DR severity per modified Davis staging: 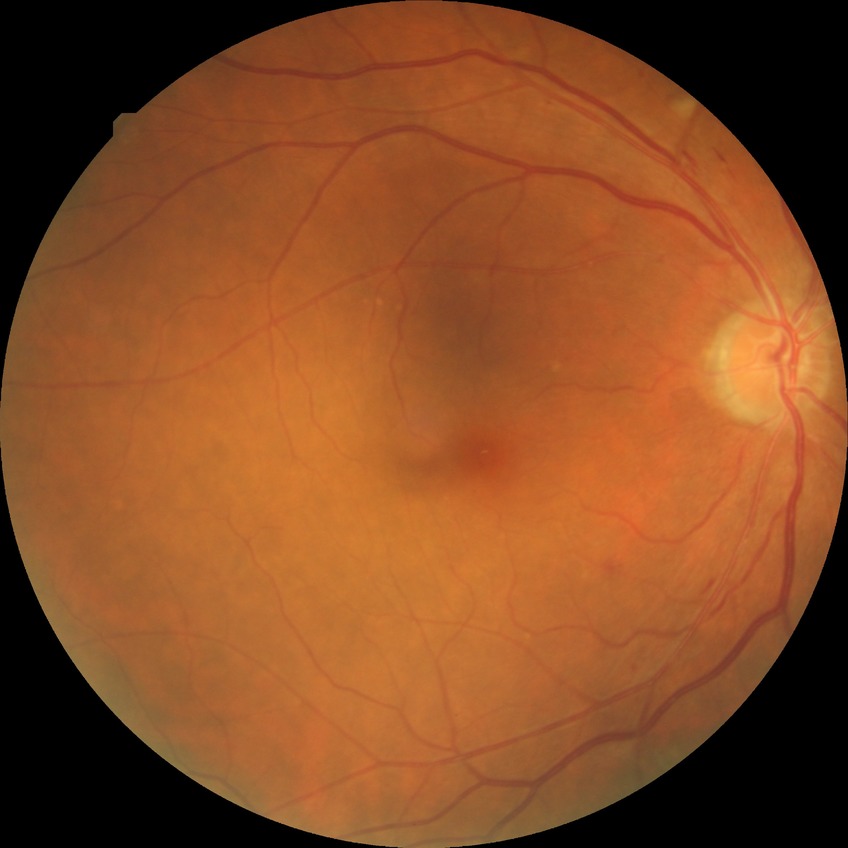 DR class: non-proliferative diabetic retinopathy; diabetic retinopathy (DR): PPDR (pre-proliferative diabetic retinopathy).